FOV: 45 degrees, image size 2212x1659, color fundus image
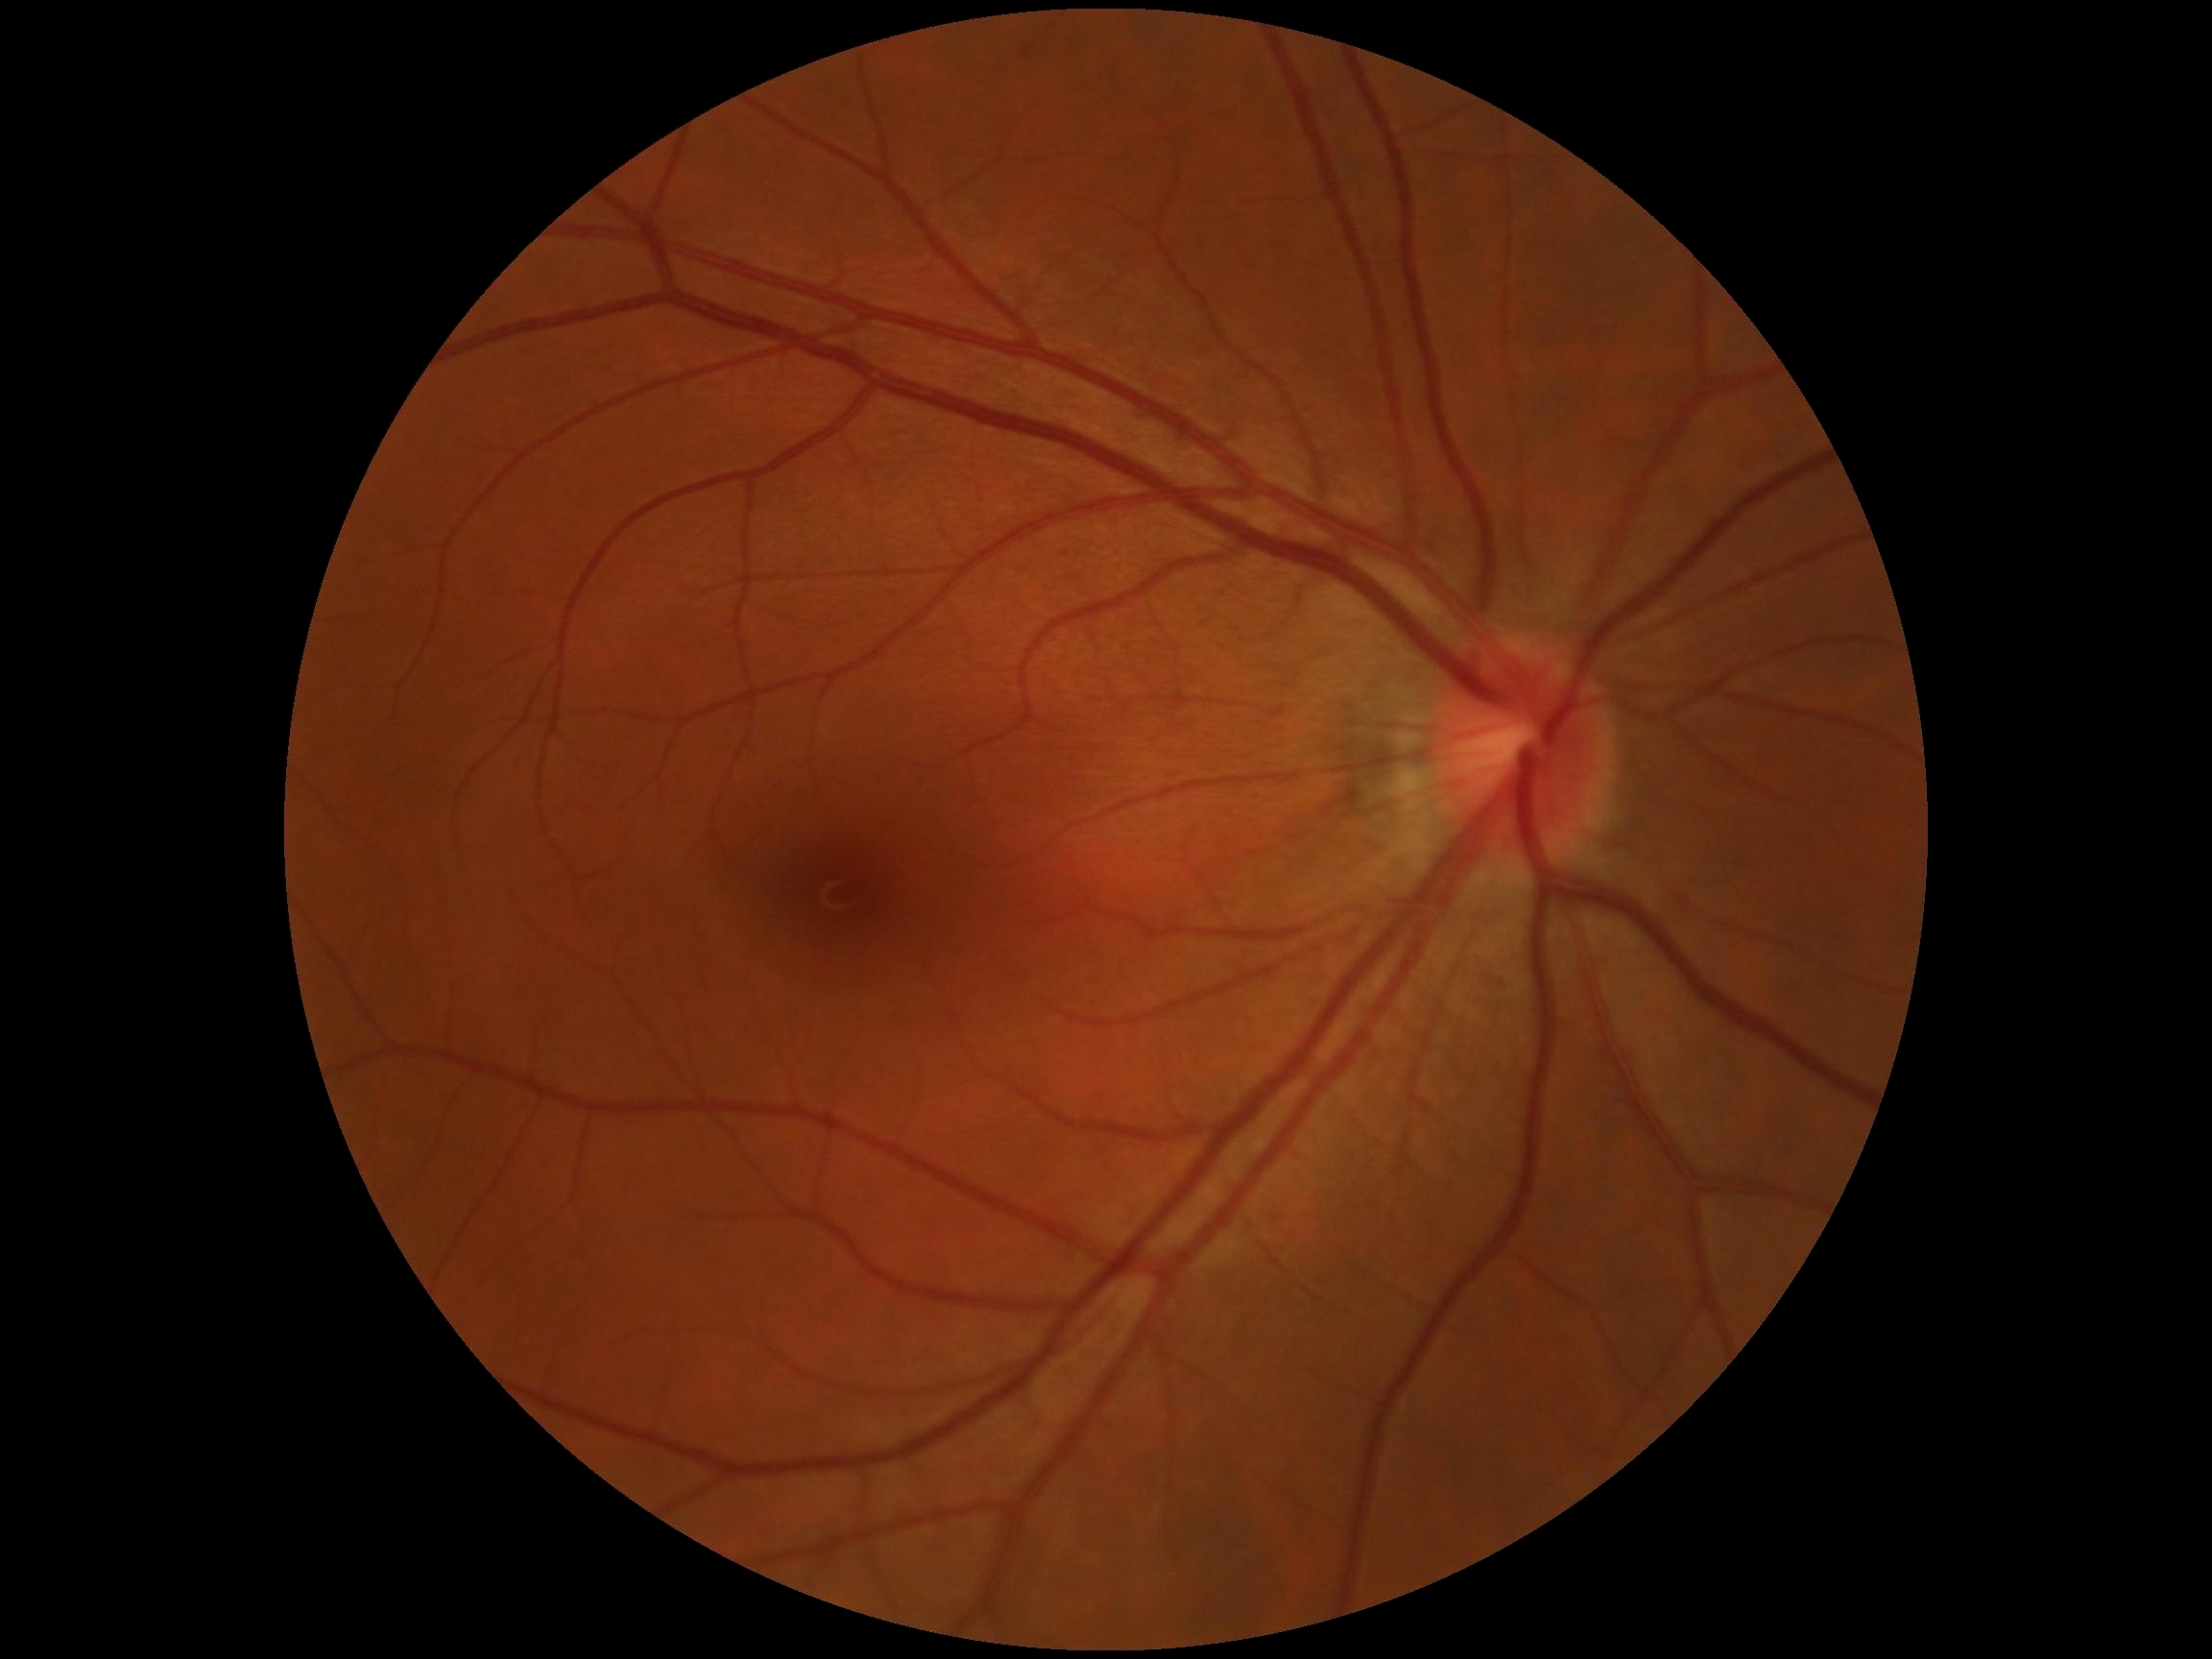

DR stage is grade 0.
No diabetic retinal disease findings.